45-degree field of view:
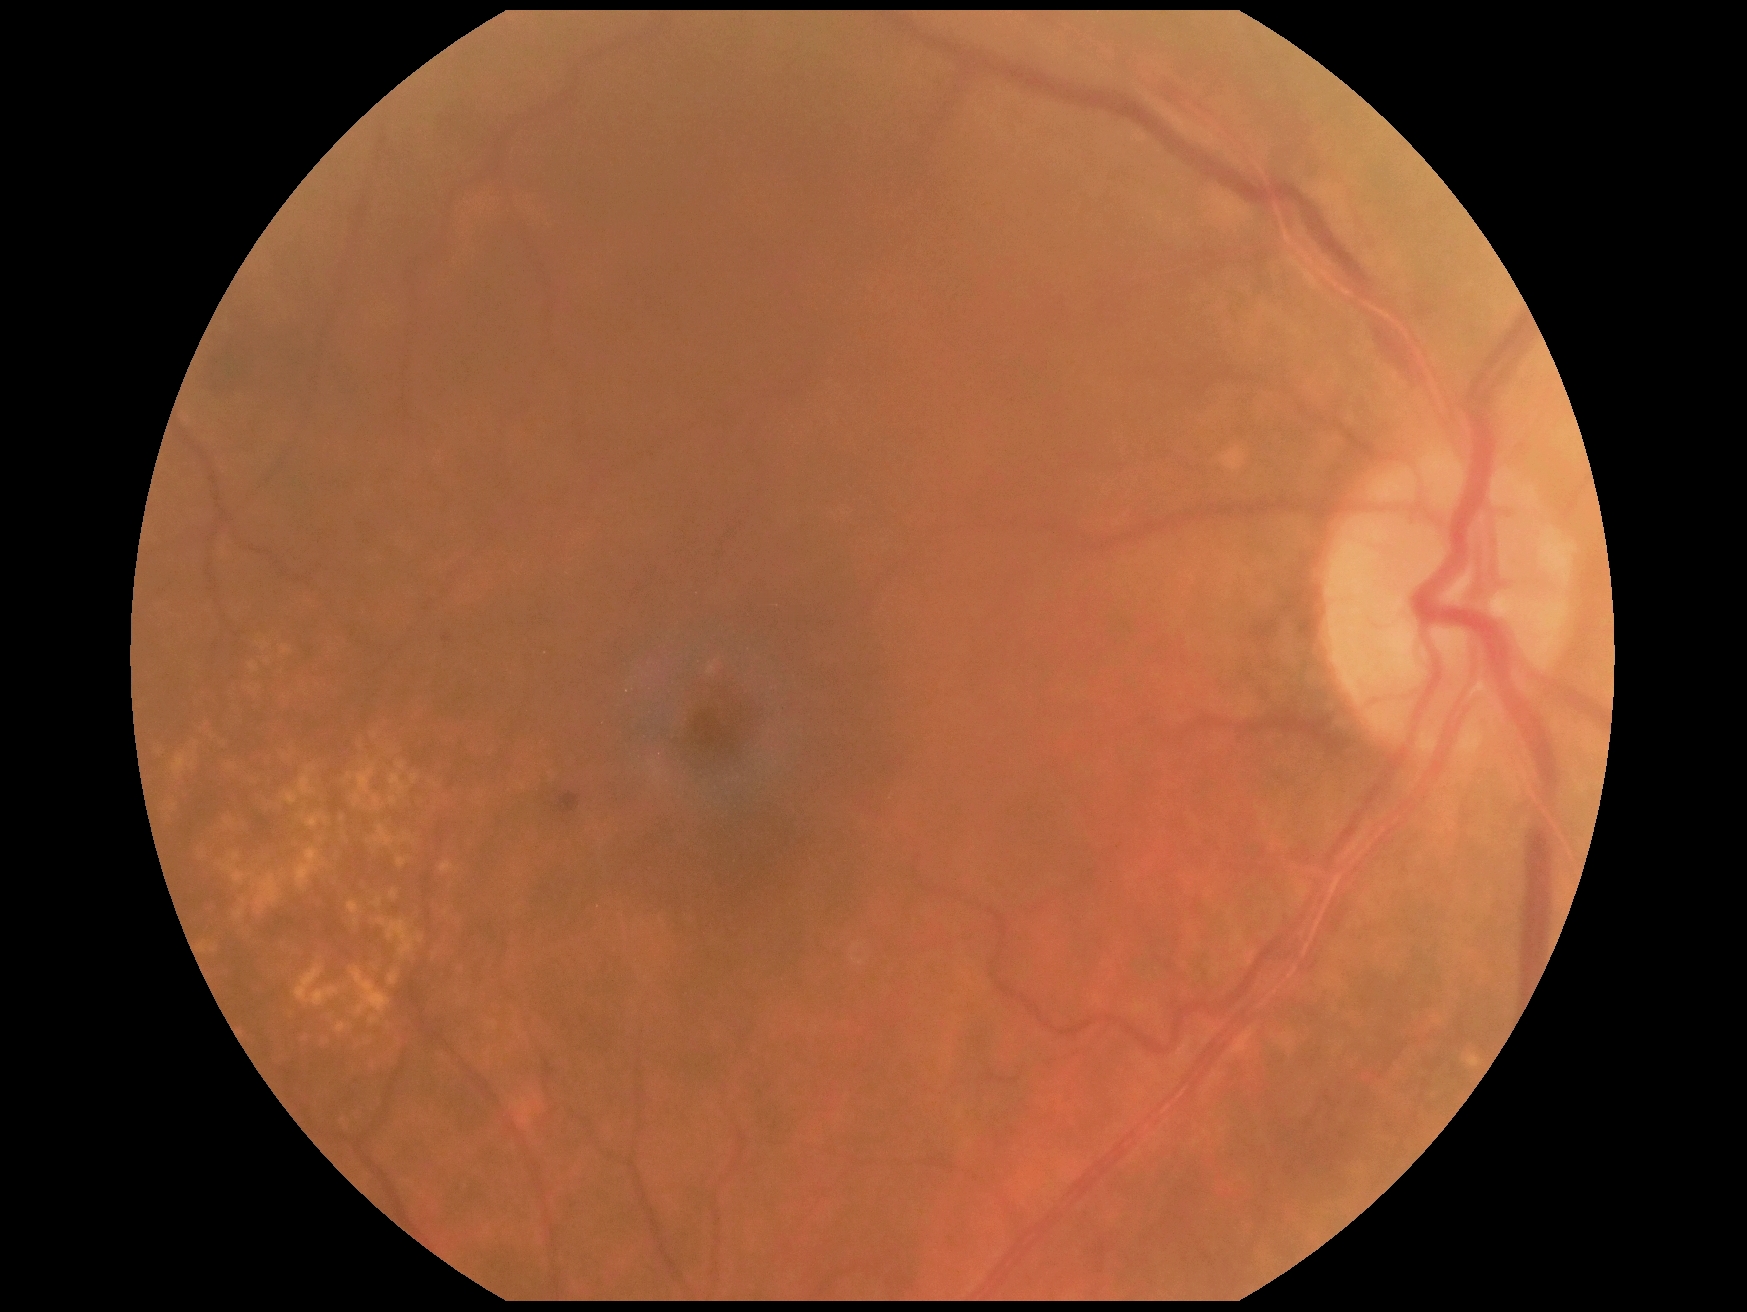
Diabetic retinopathy severity: moderate NPDR (grade 2) — more than just microaneurysms but less than severe NPDR.